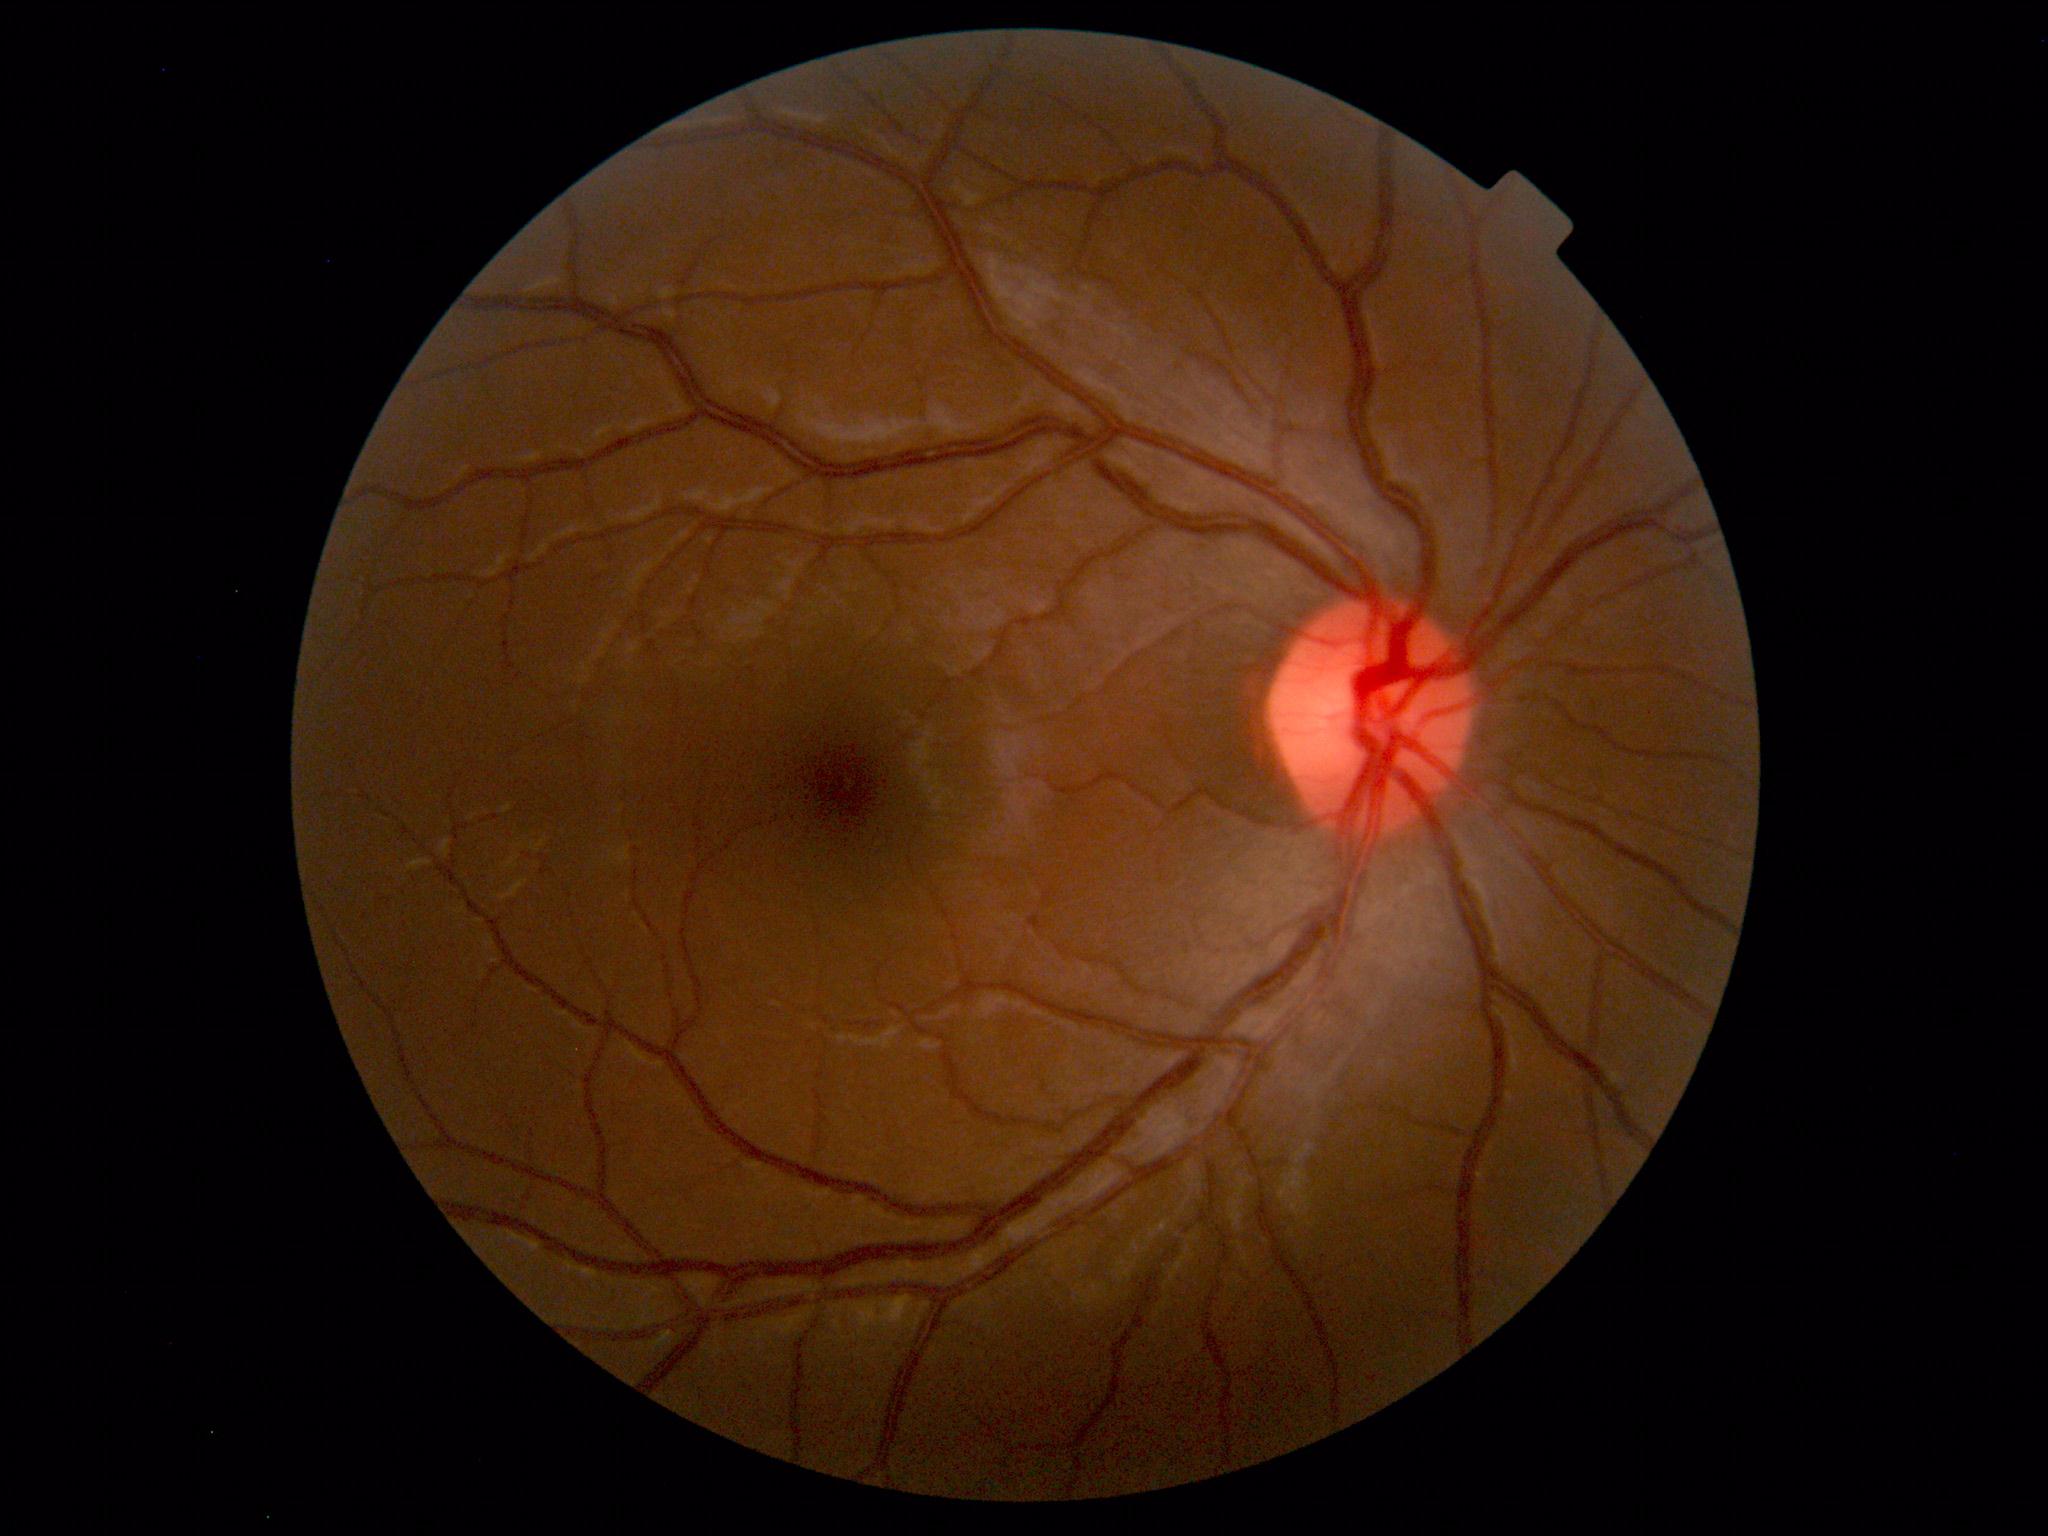

Within normal limits. No abnormalities identified.